Without pupil dilation. Acquired with a NIDEK AFC-230. CFP — 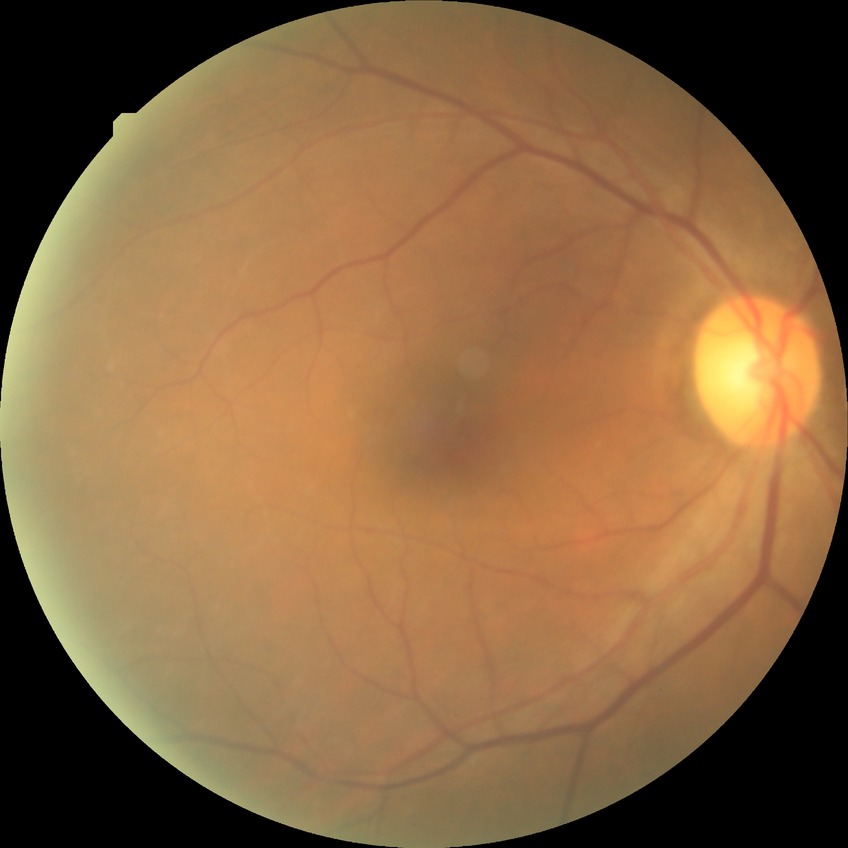 Davis grade: SDR